Captured on a Forus 3Nethra Classic:
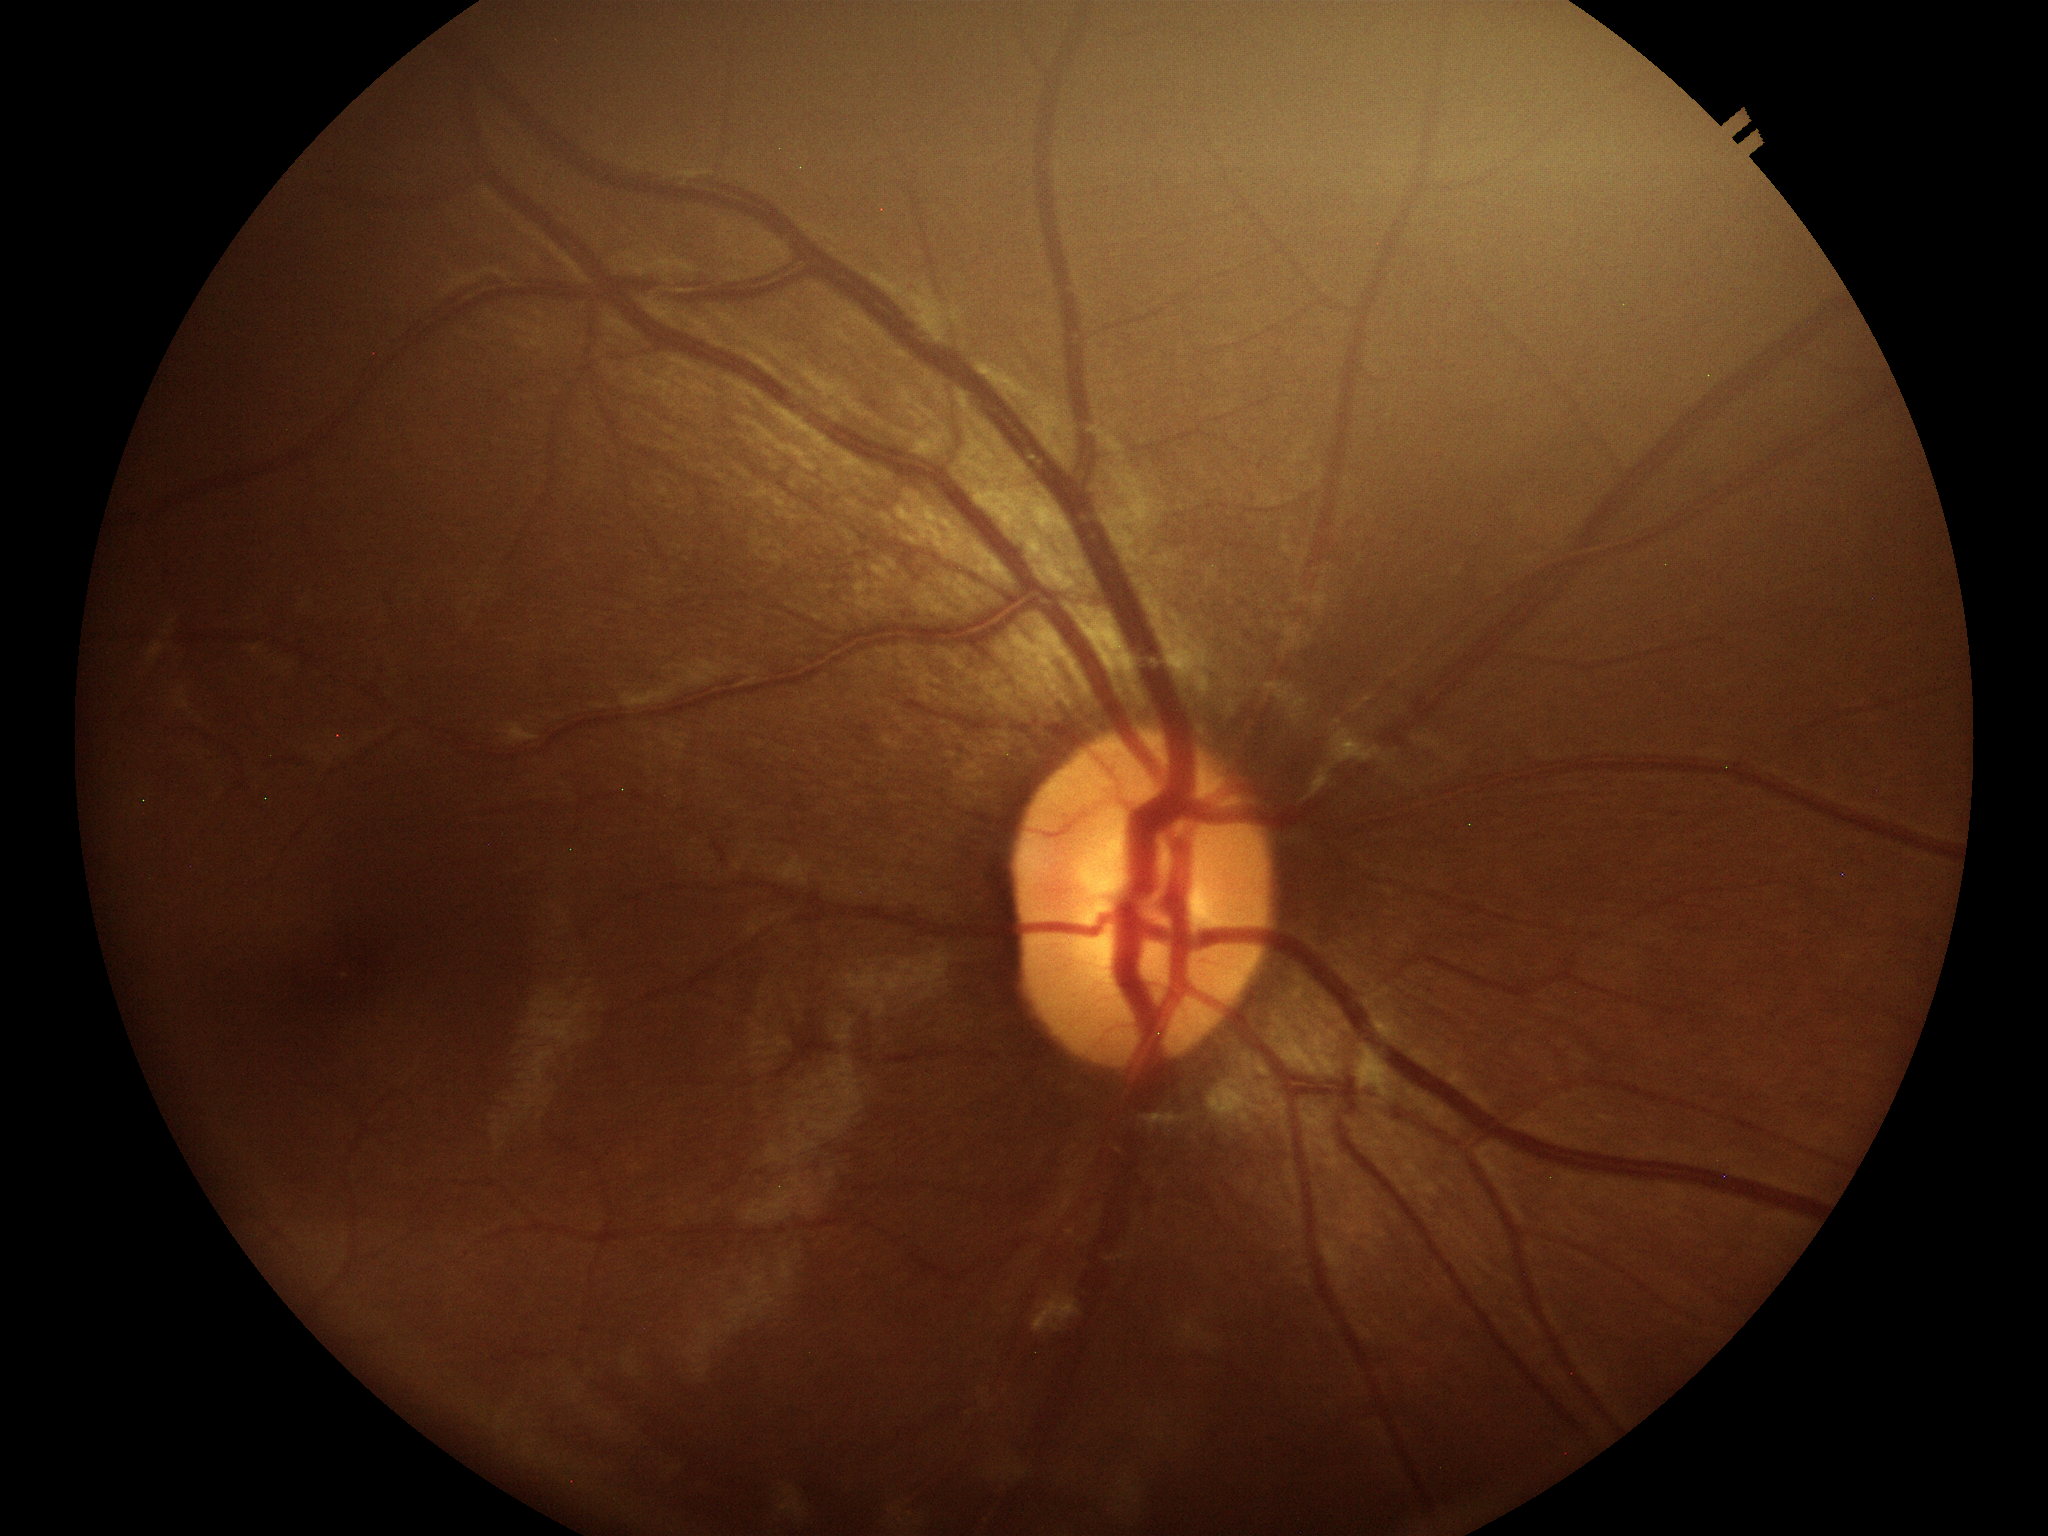
VCDR of 0.48. ACDR is 0.22. No glaucomatous findings (1 of 5 graders flagged glaucoma suspect).